Image size 2212x1659, 45° FOV, retinal fundus photograph: 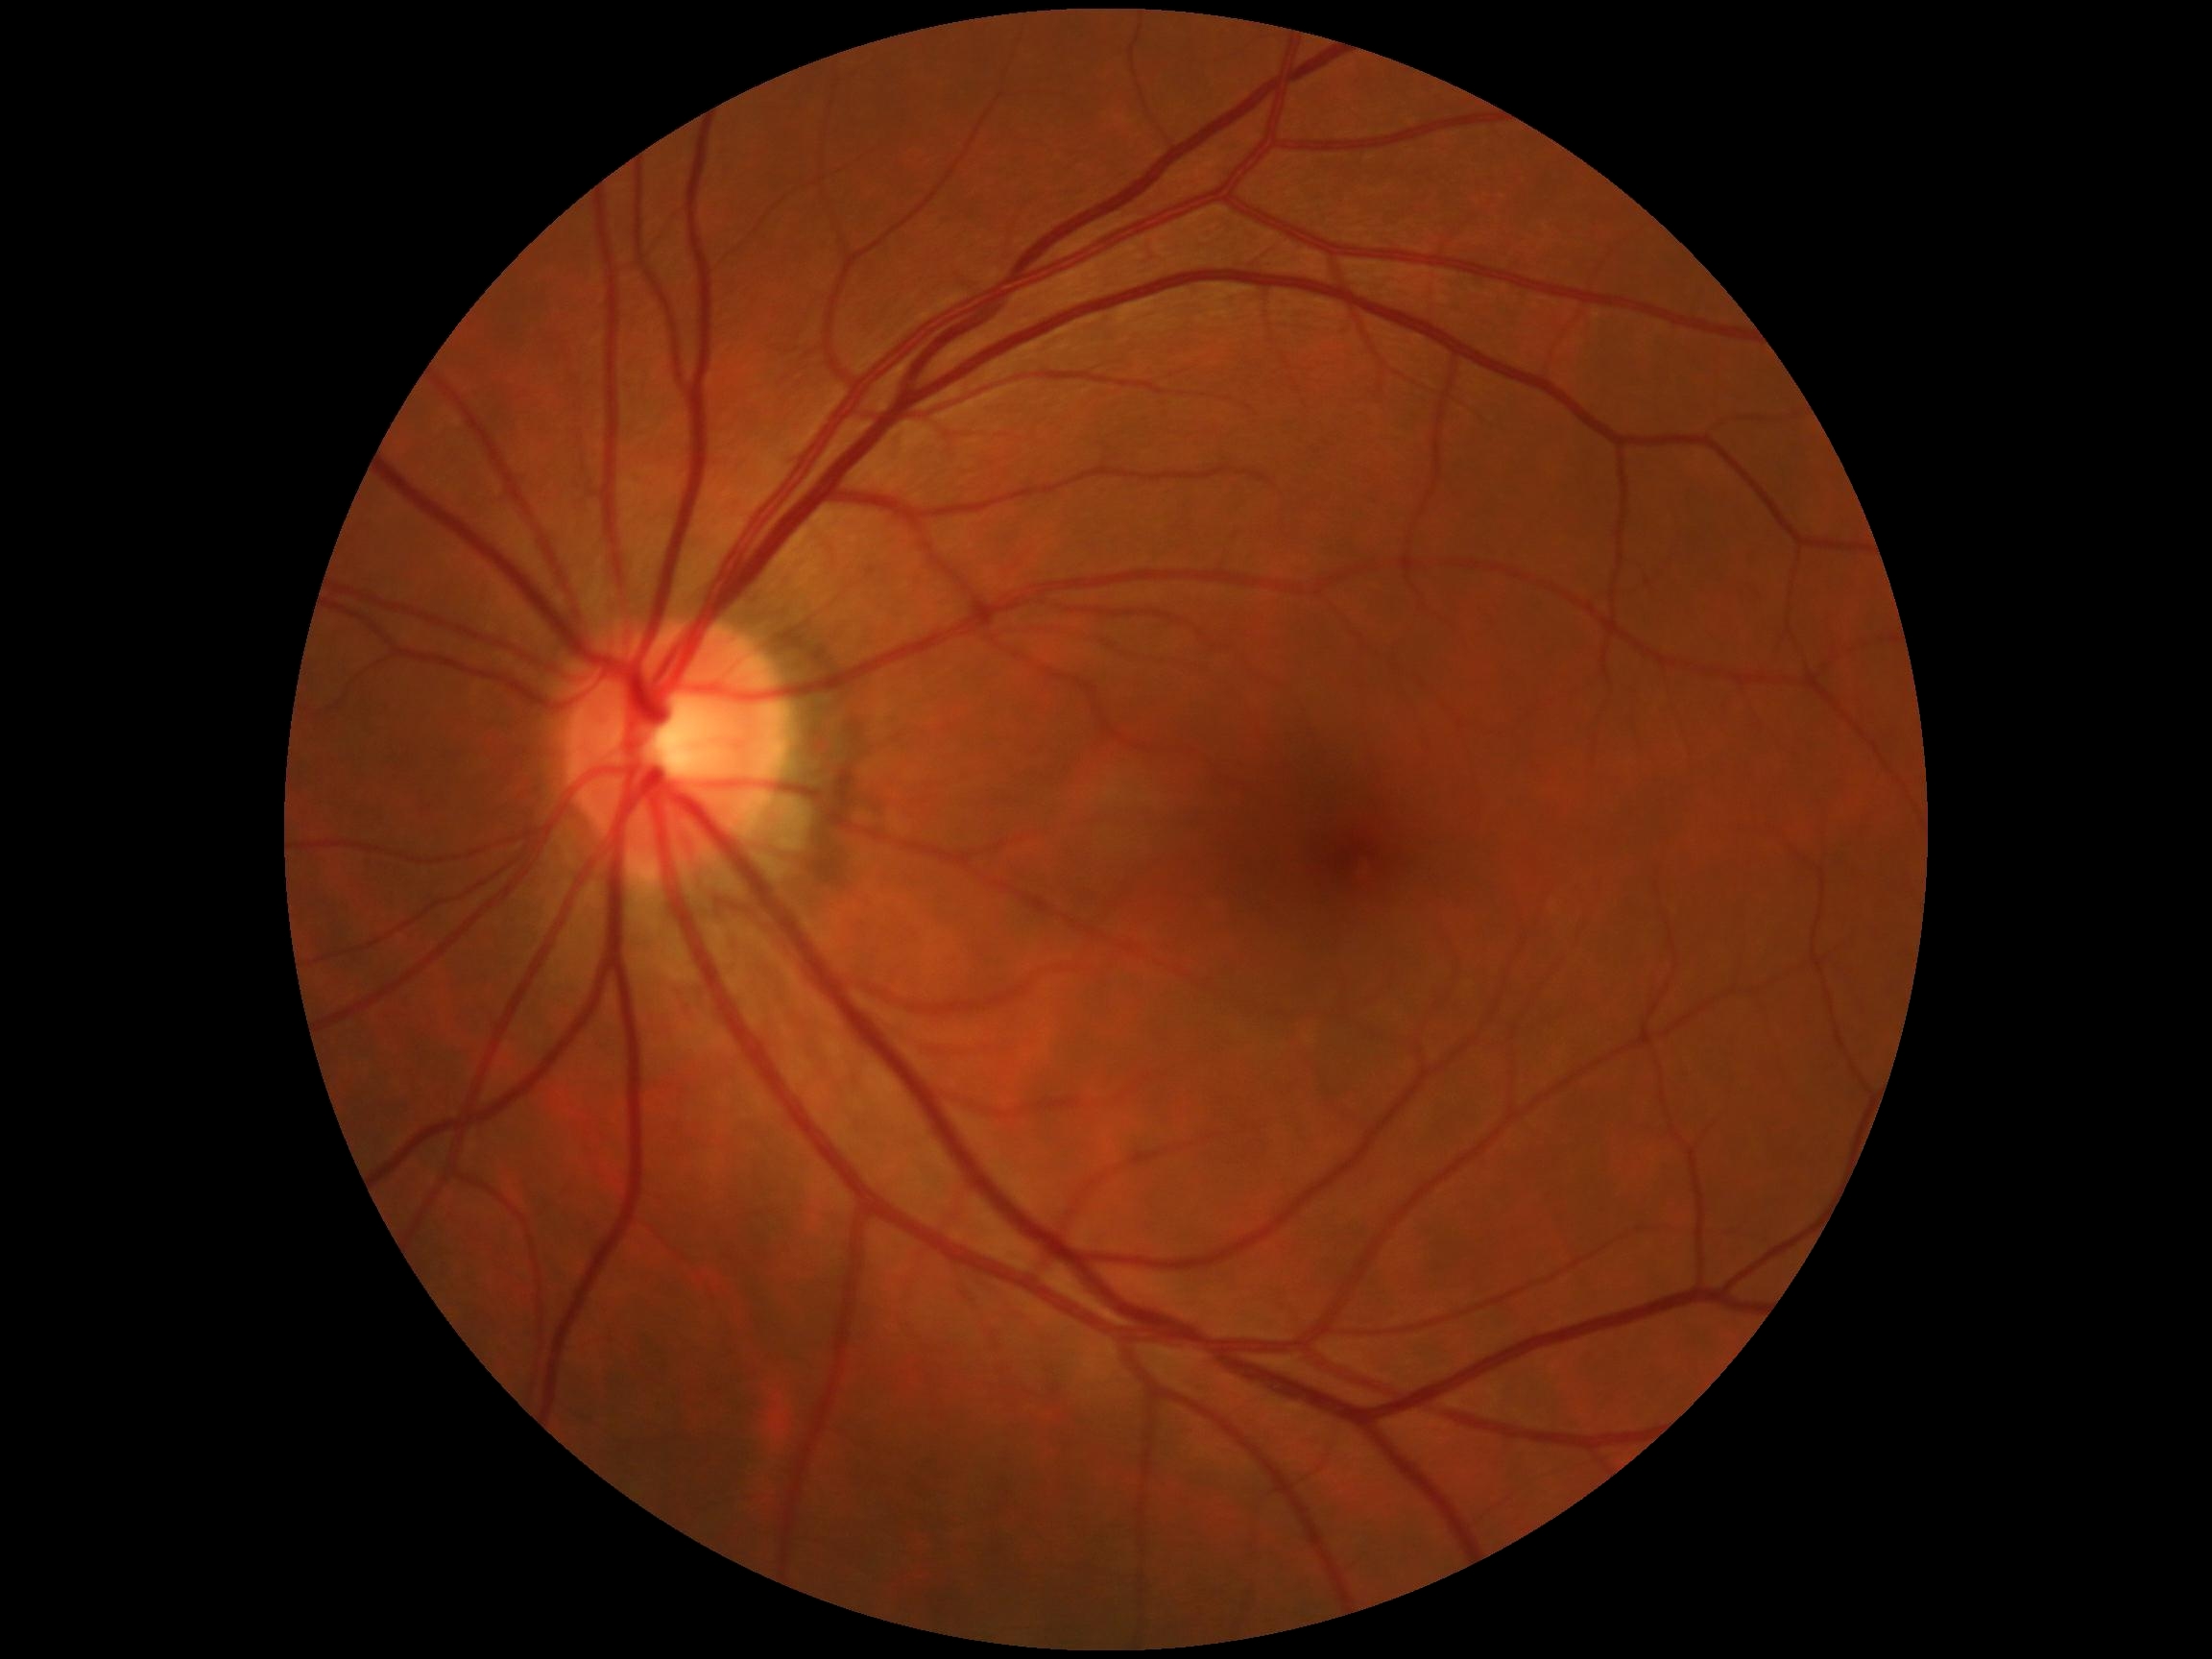

DR: no apparent diabetic retinopathy (grade 0) — no visible signs of diabetic retinopathy.